45 degree fundus photograph; nonmydriatic; NIDEK AFC-230
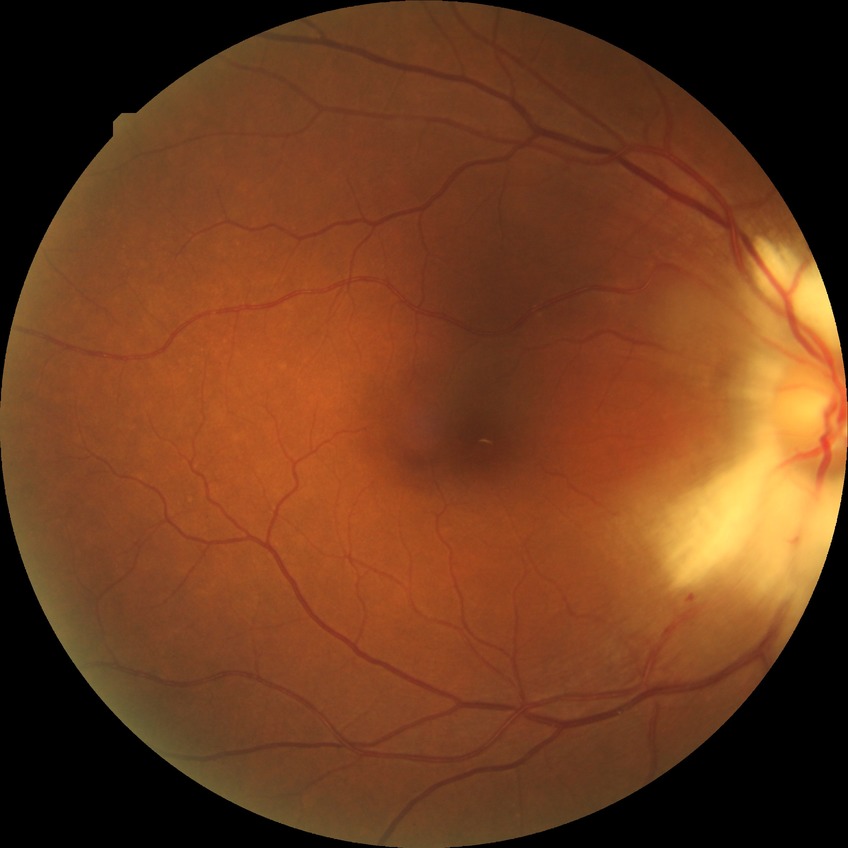 Assessment:
- diabetic retinopathy (DR) — NDR (no diabetic retinopathy)